Image size 1536x1152
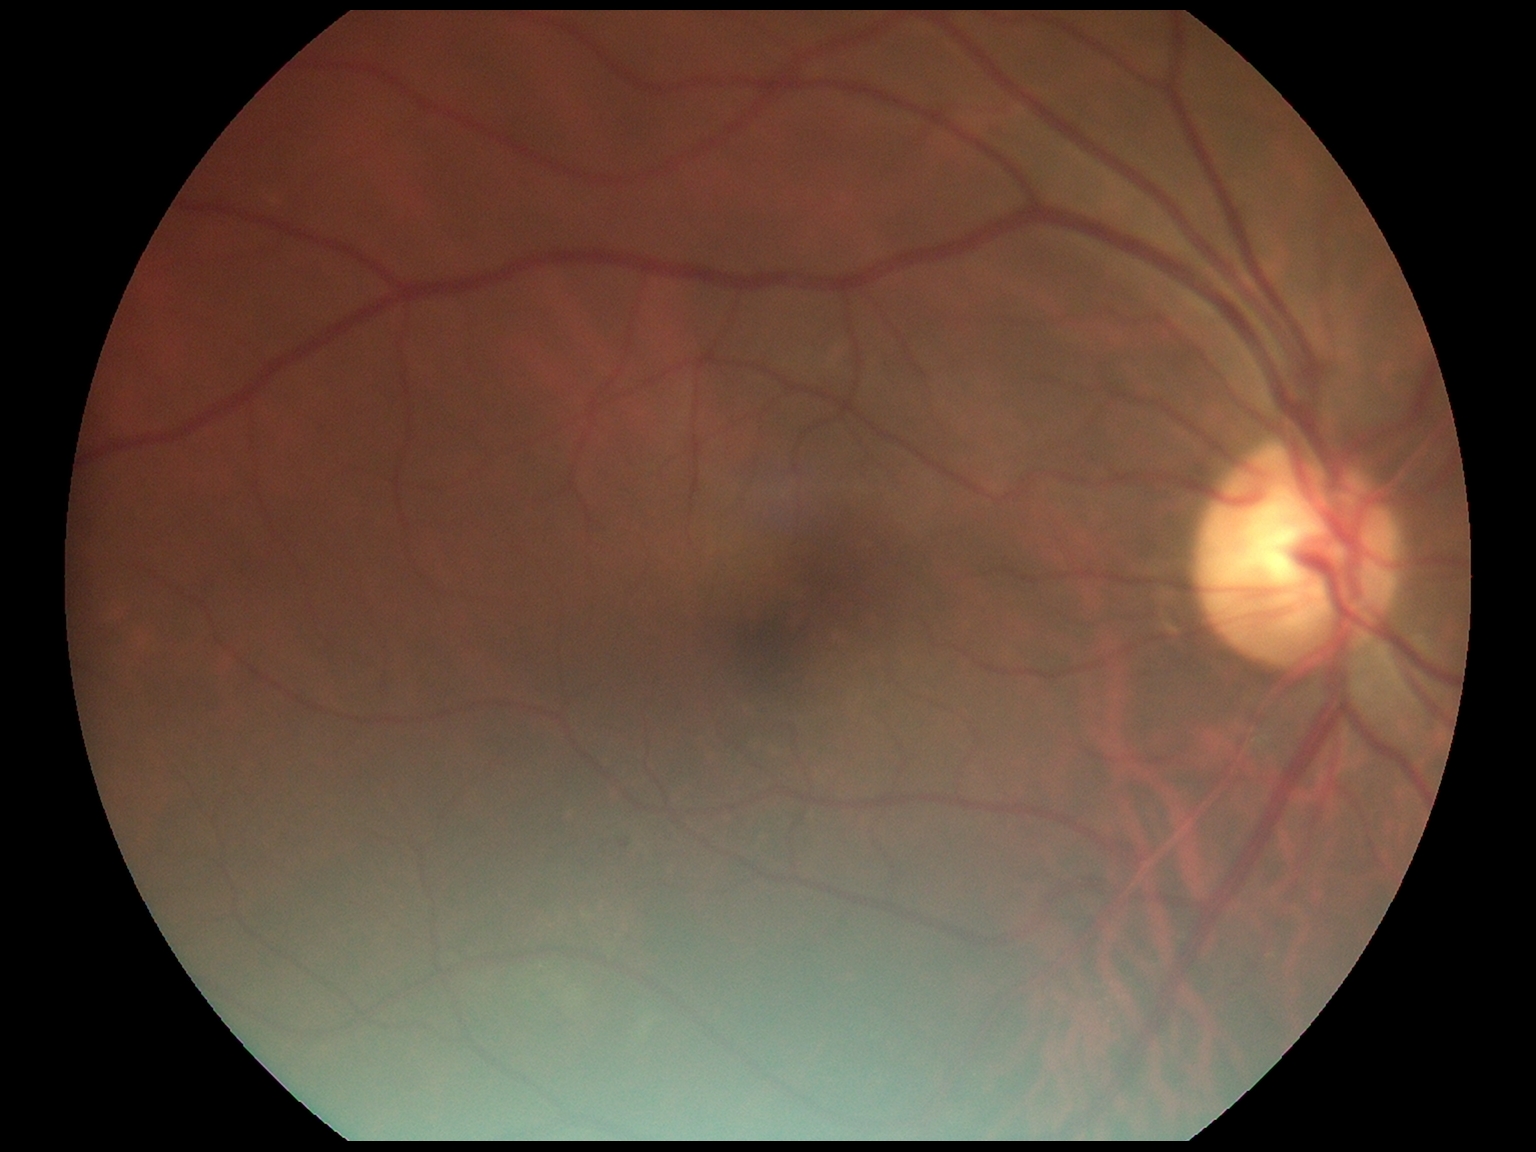
DR grade: 1 (mild NPDR).